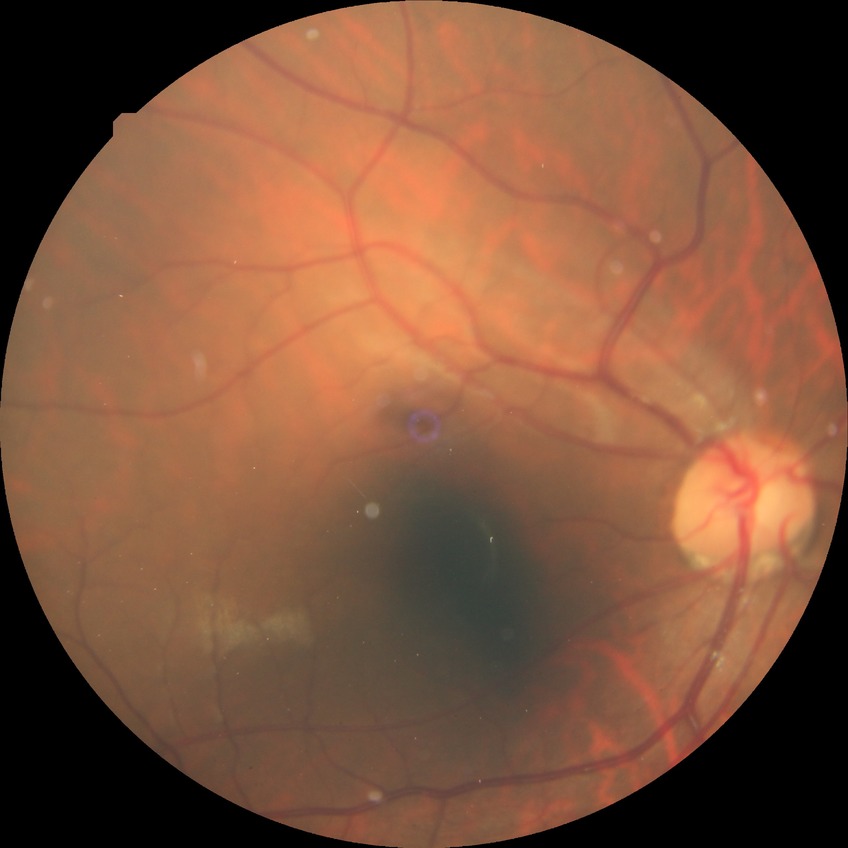
Davis grading: no diabetic retinopathy.